Wide-field fundus photograph from neonatal ROP screening — 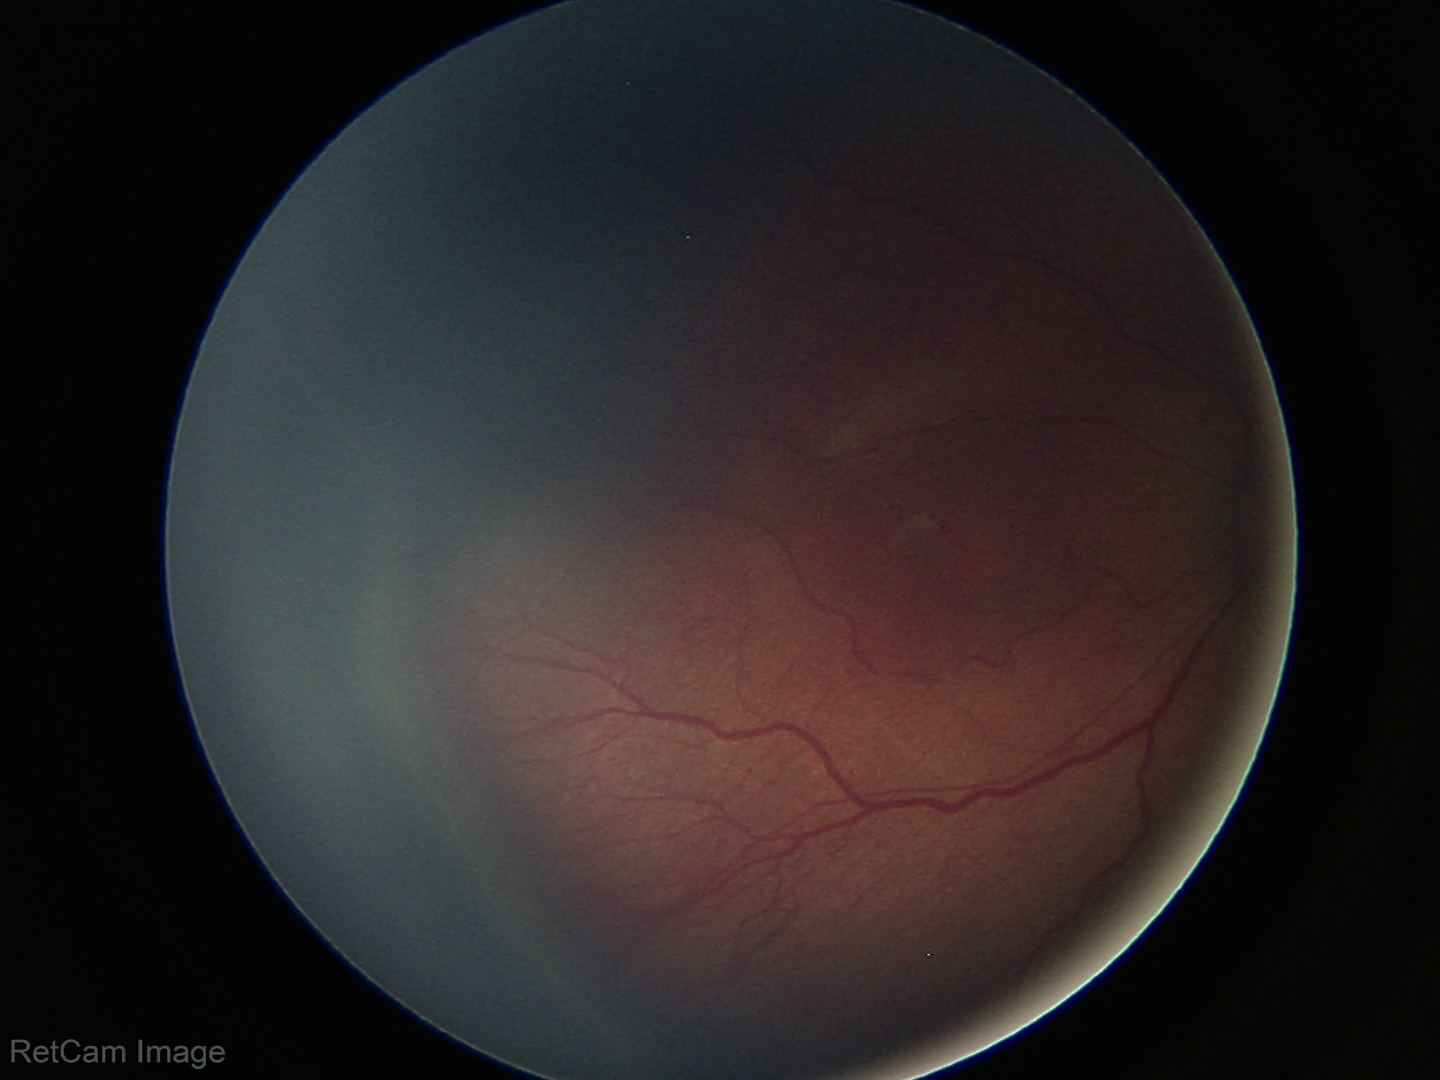

Plus disease absent. Screening examination consistent with retinopathy of prematurity stage 3.